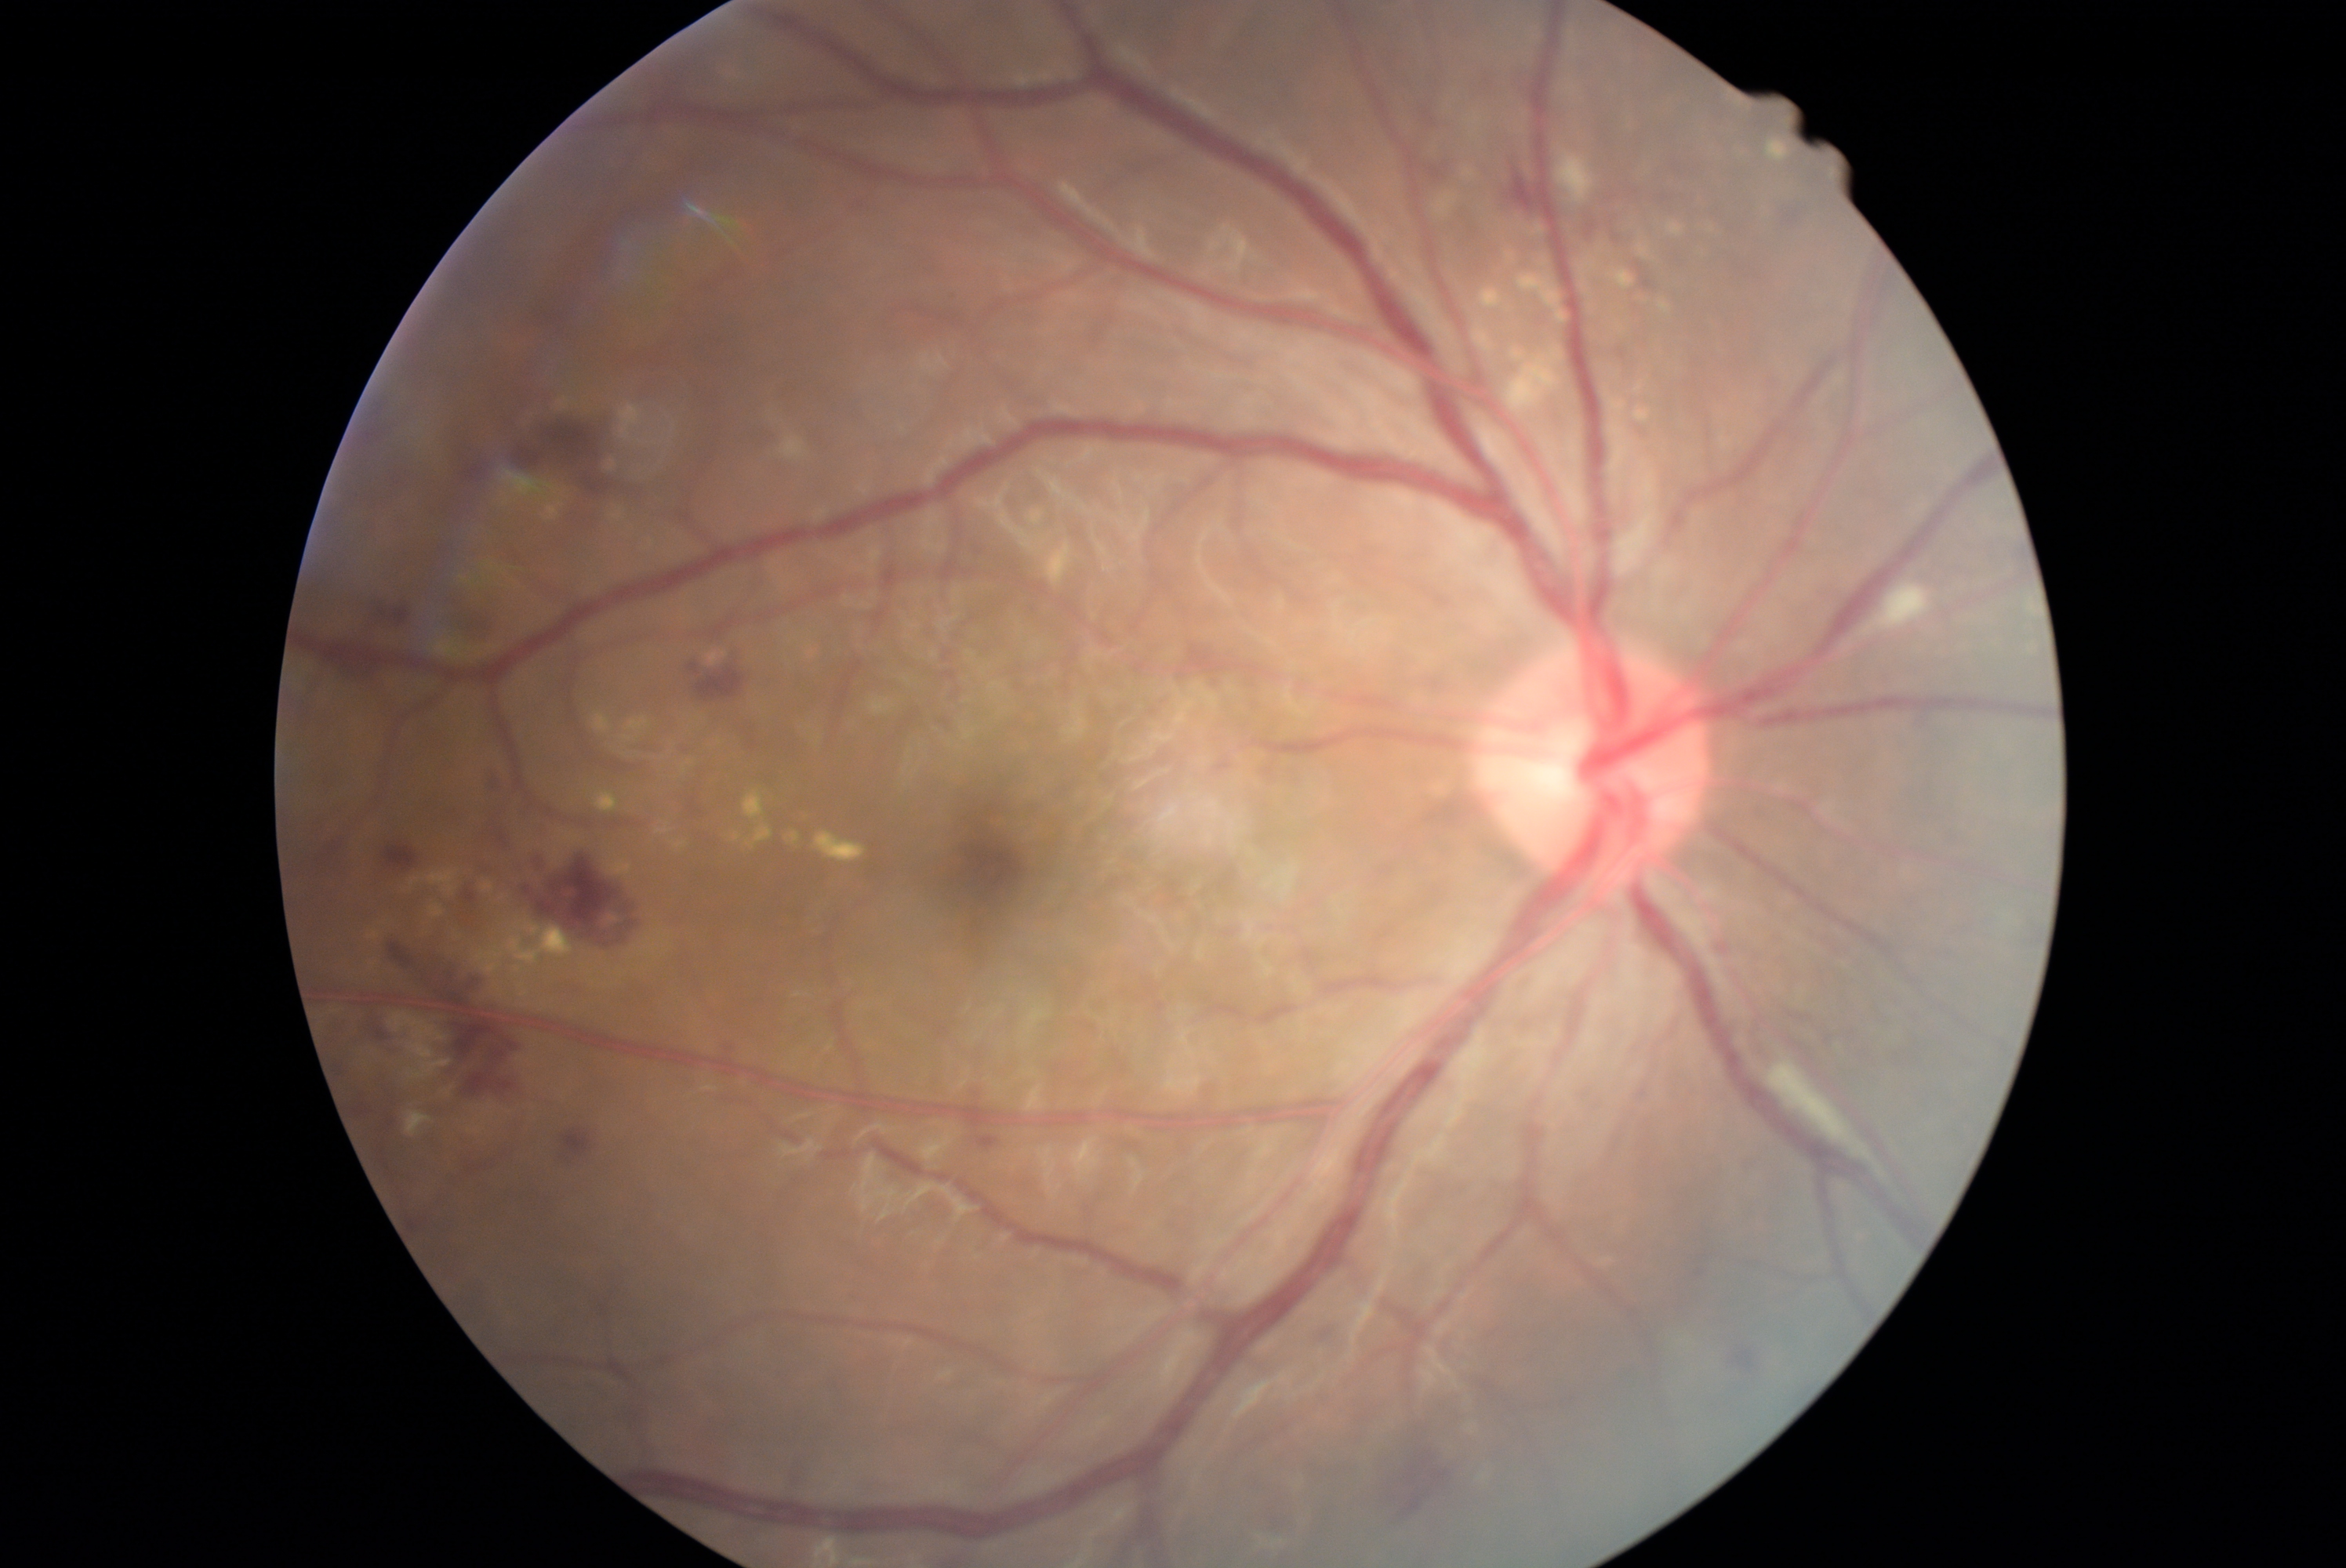 DR stage: 2/4.